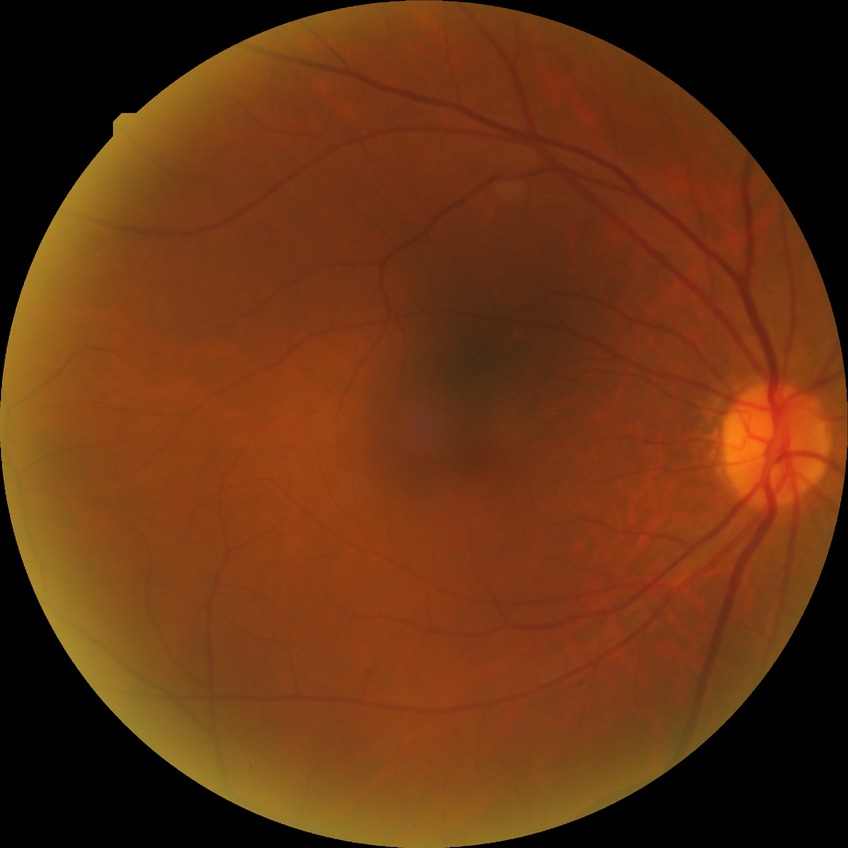 Diabetic retinopathy (DR): SDR (simple diabetic retinopathy).